Color fundus image · modified Davis grading — 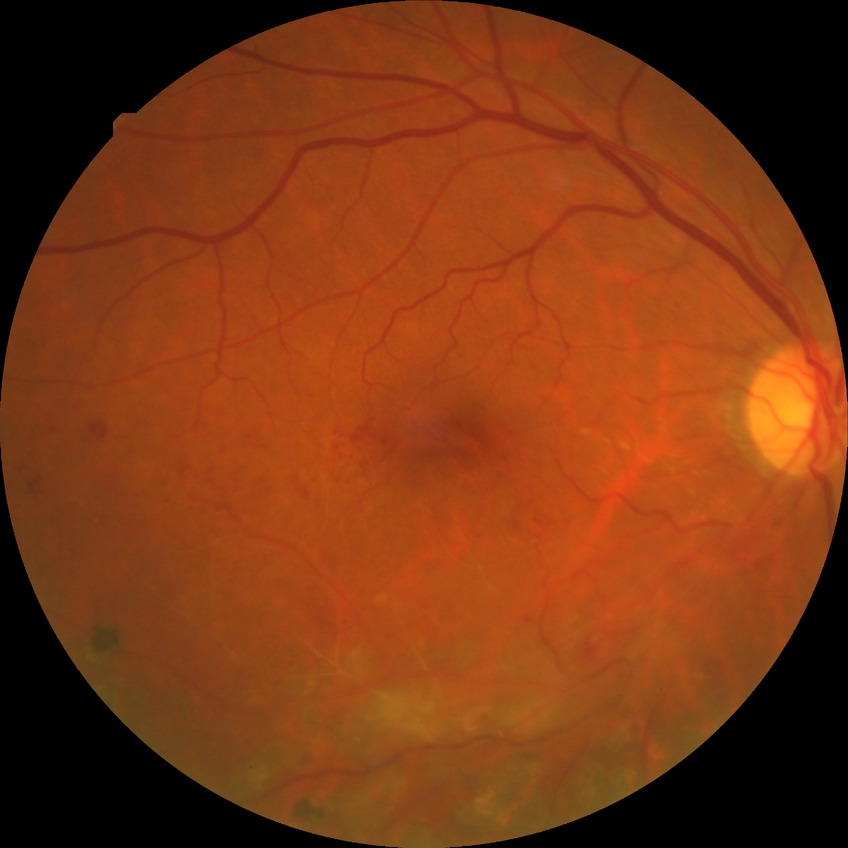 {"davis_grade": "simple diabetic retinopathy"}